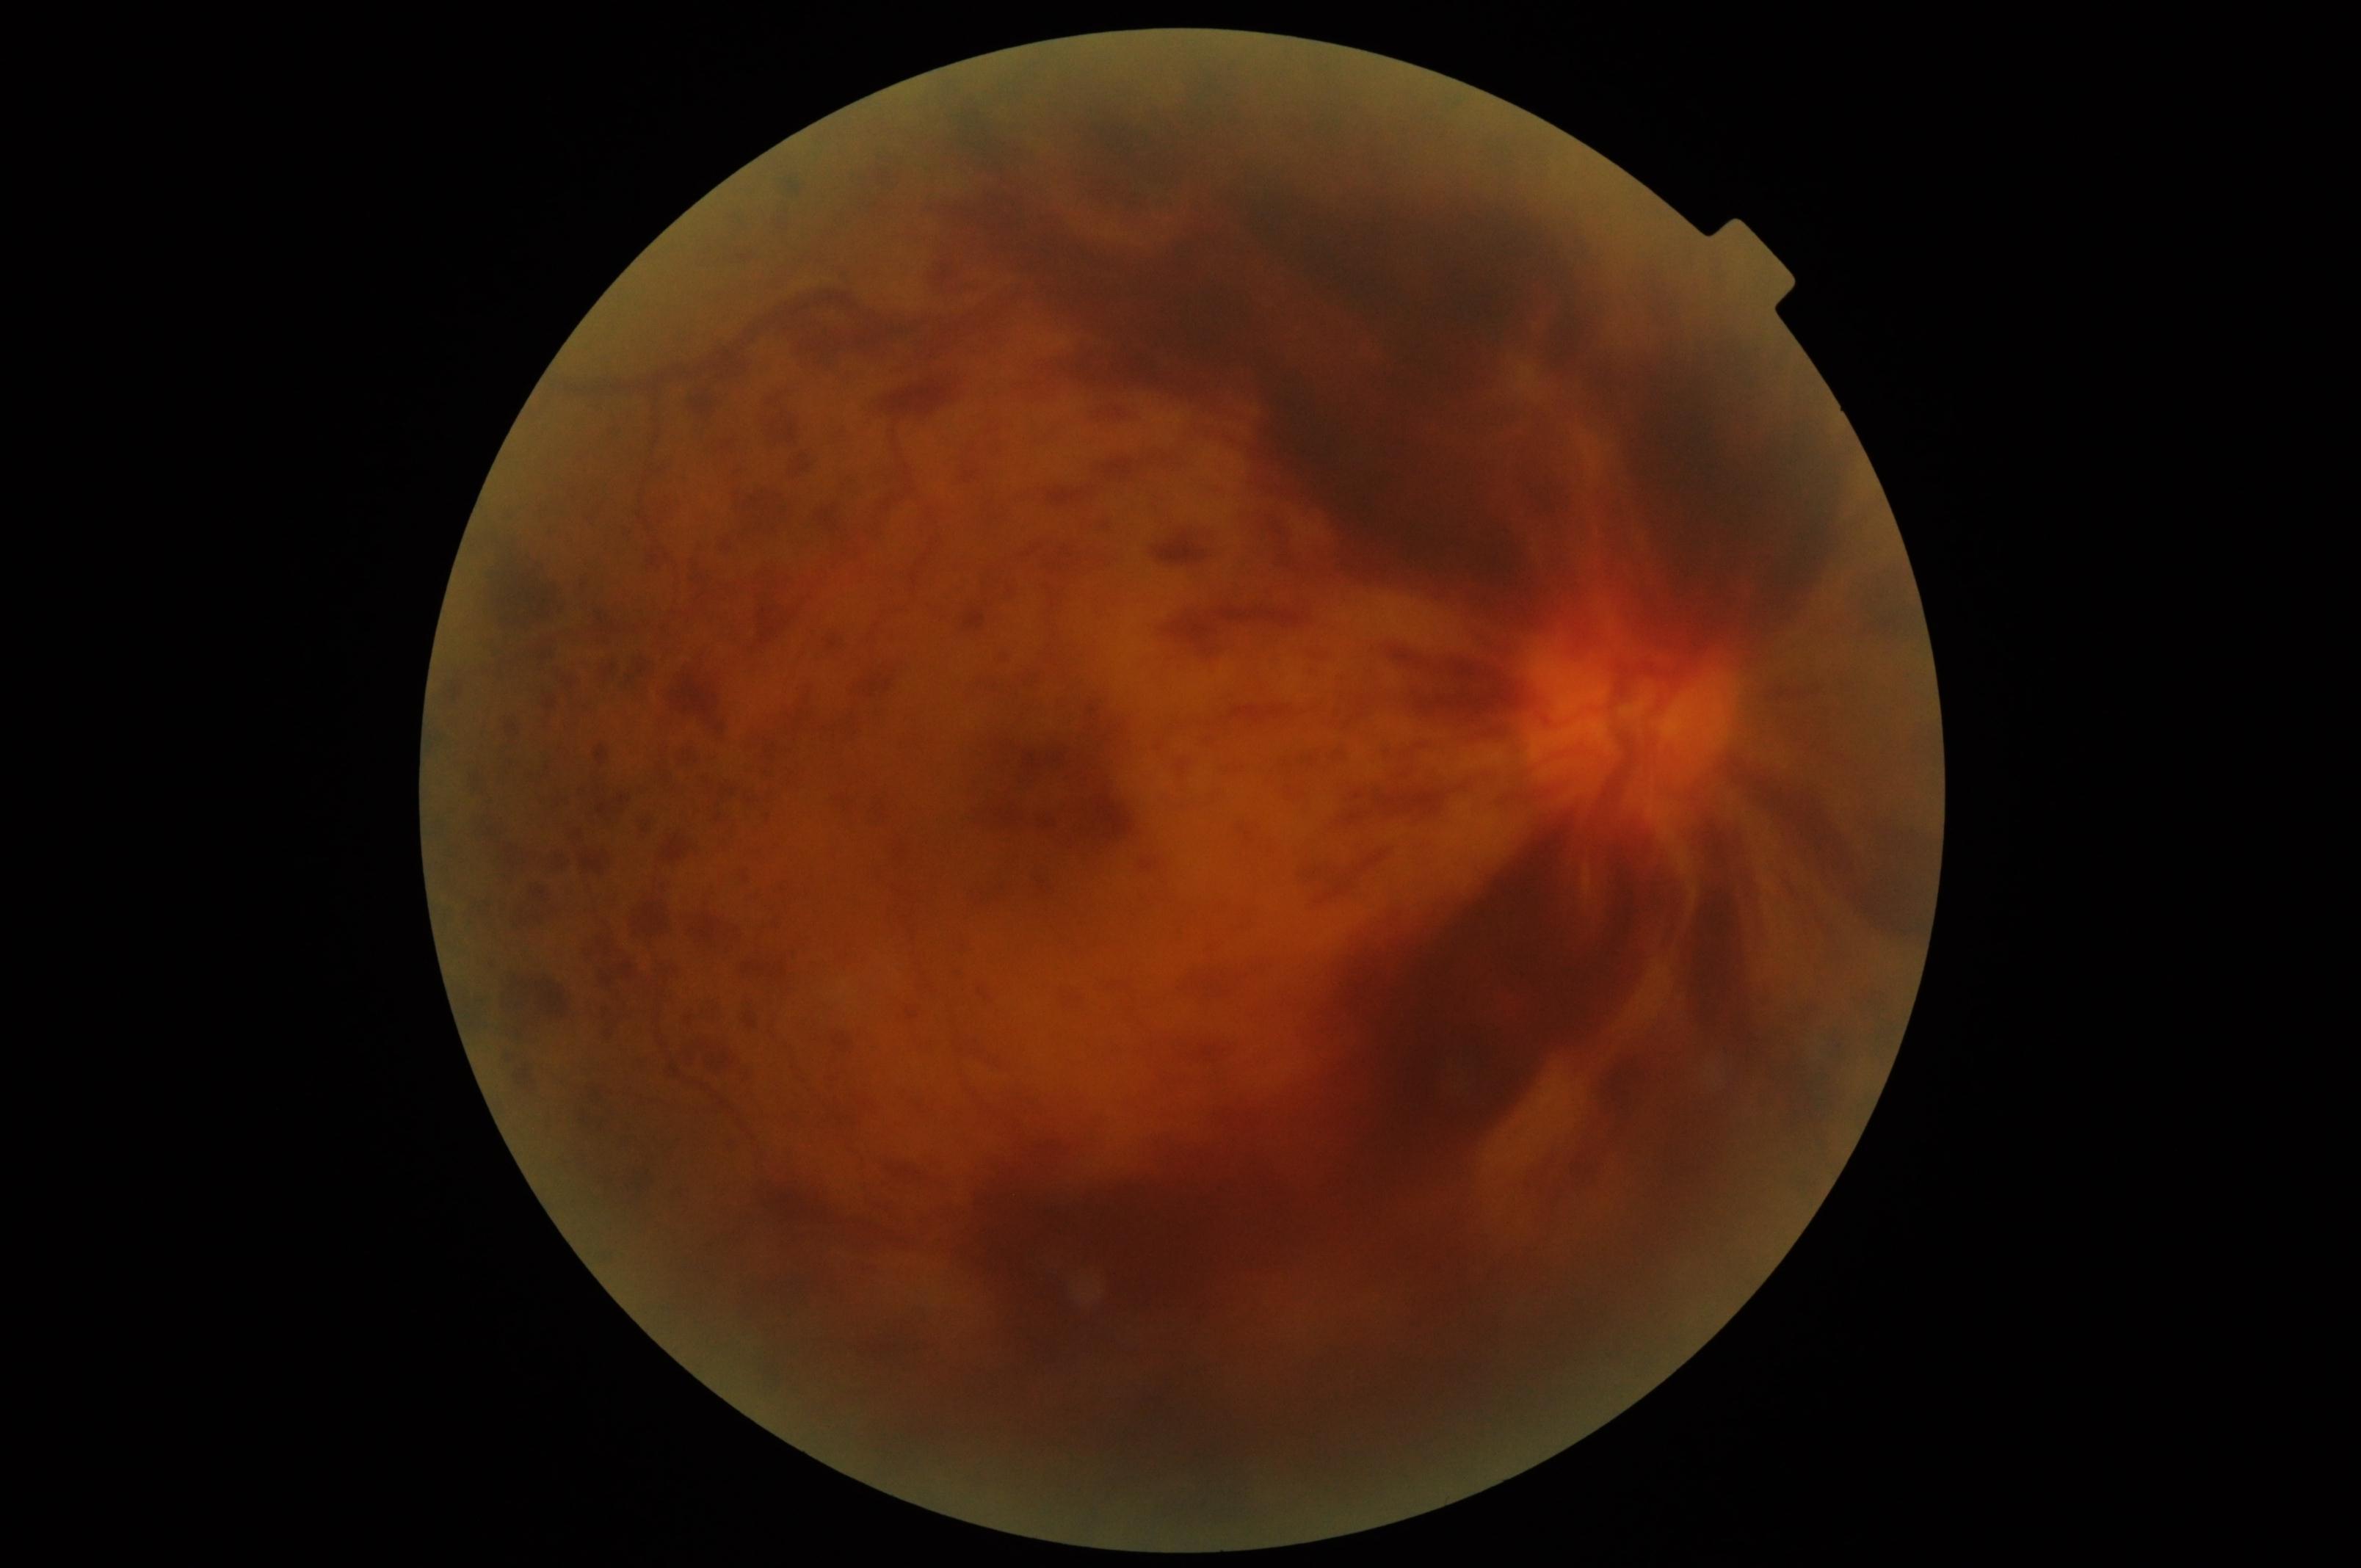
Retinopathy: proliferative diabetic retinopathy (grade 4).